CFP; no pharmacologic dilation: 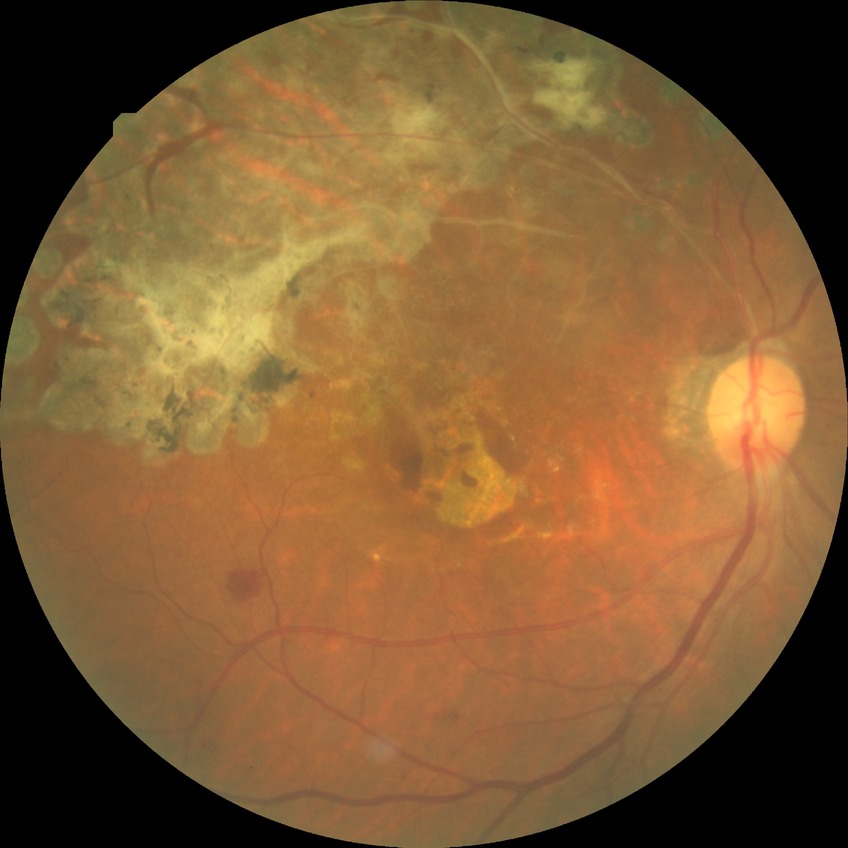
Diabetic retinopathy severity is simple diabetic retinopathy.